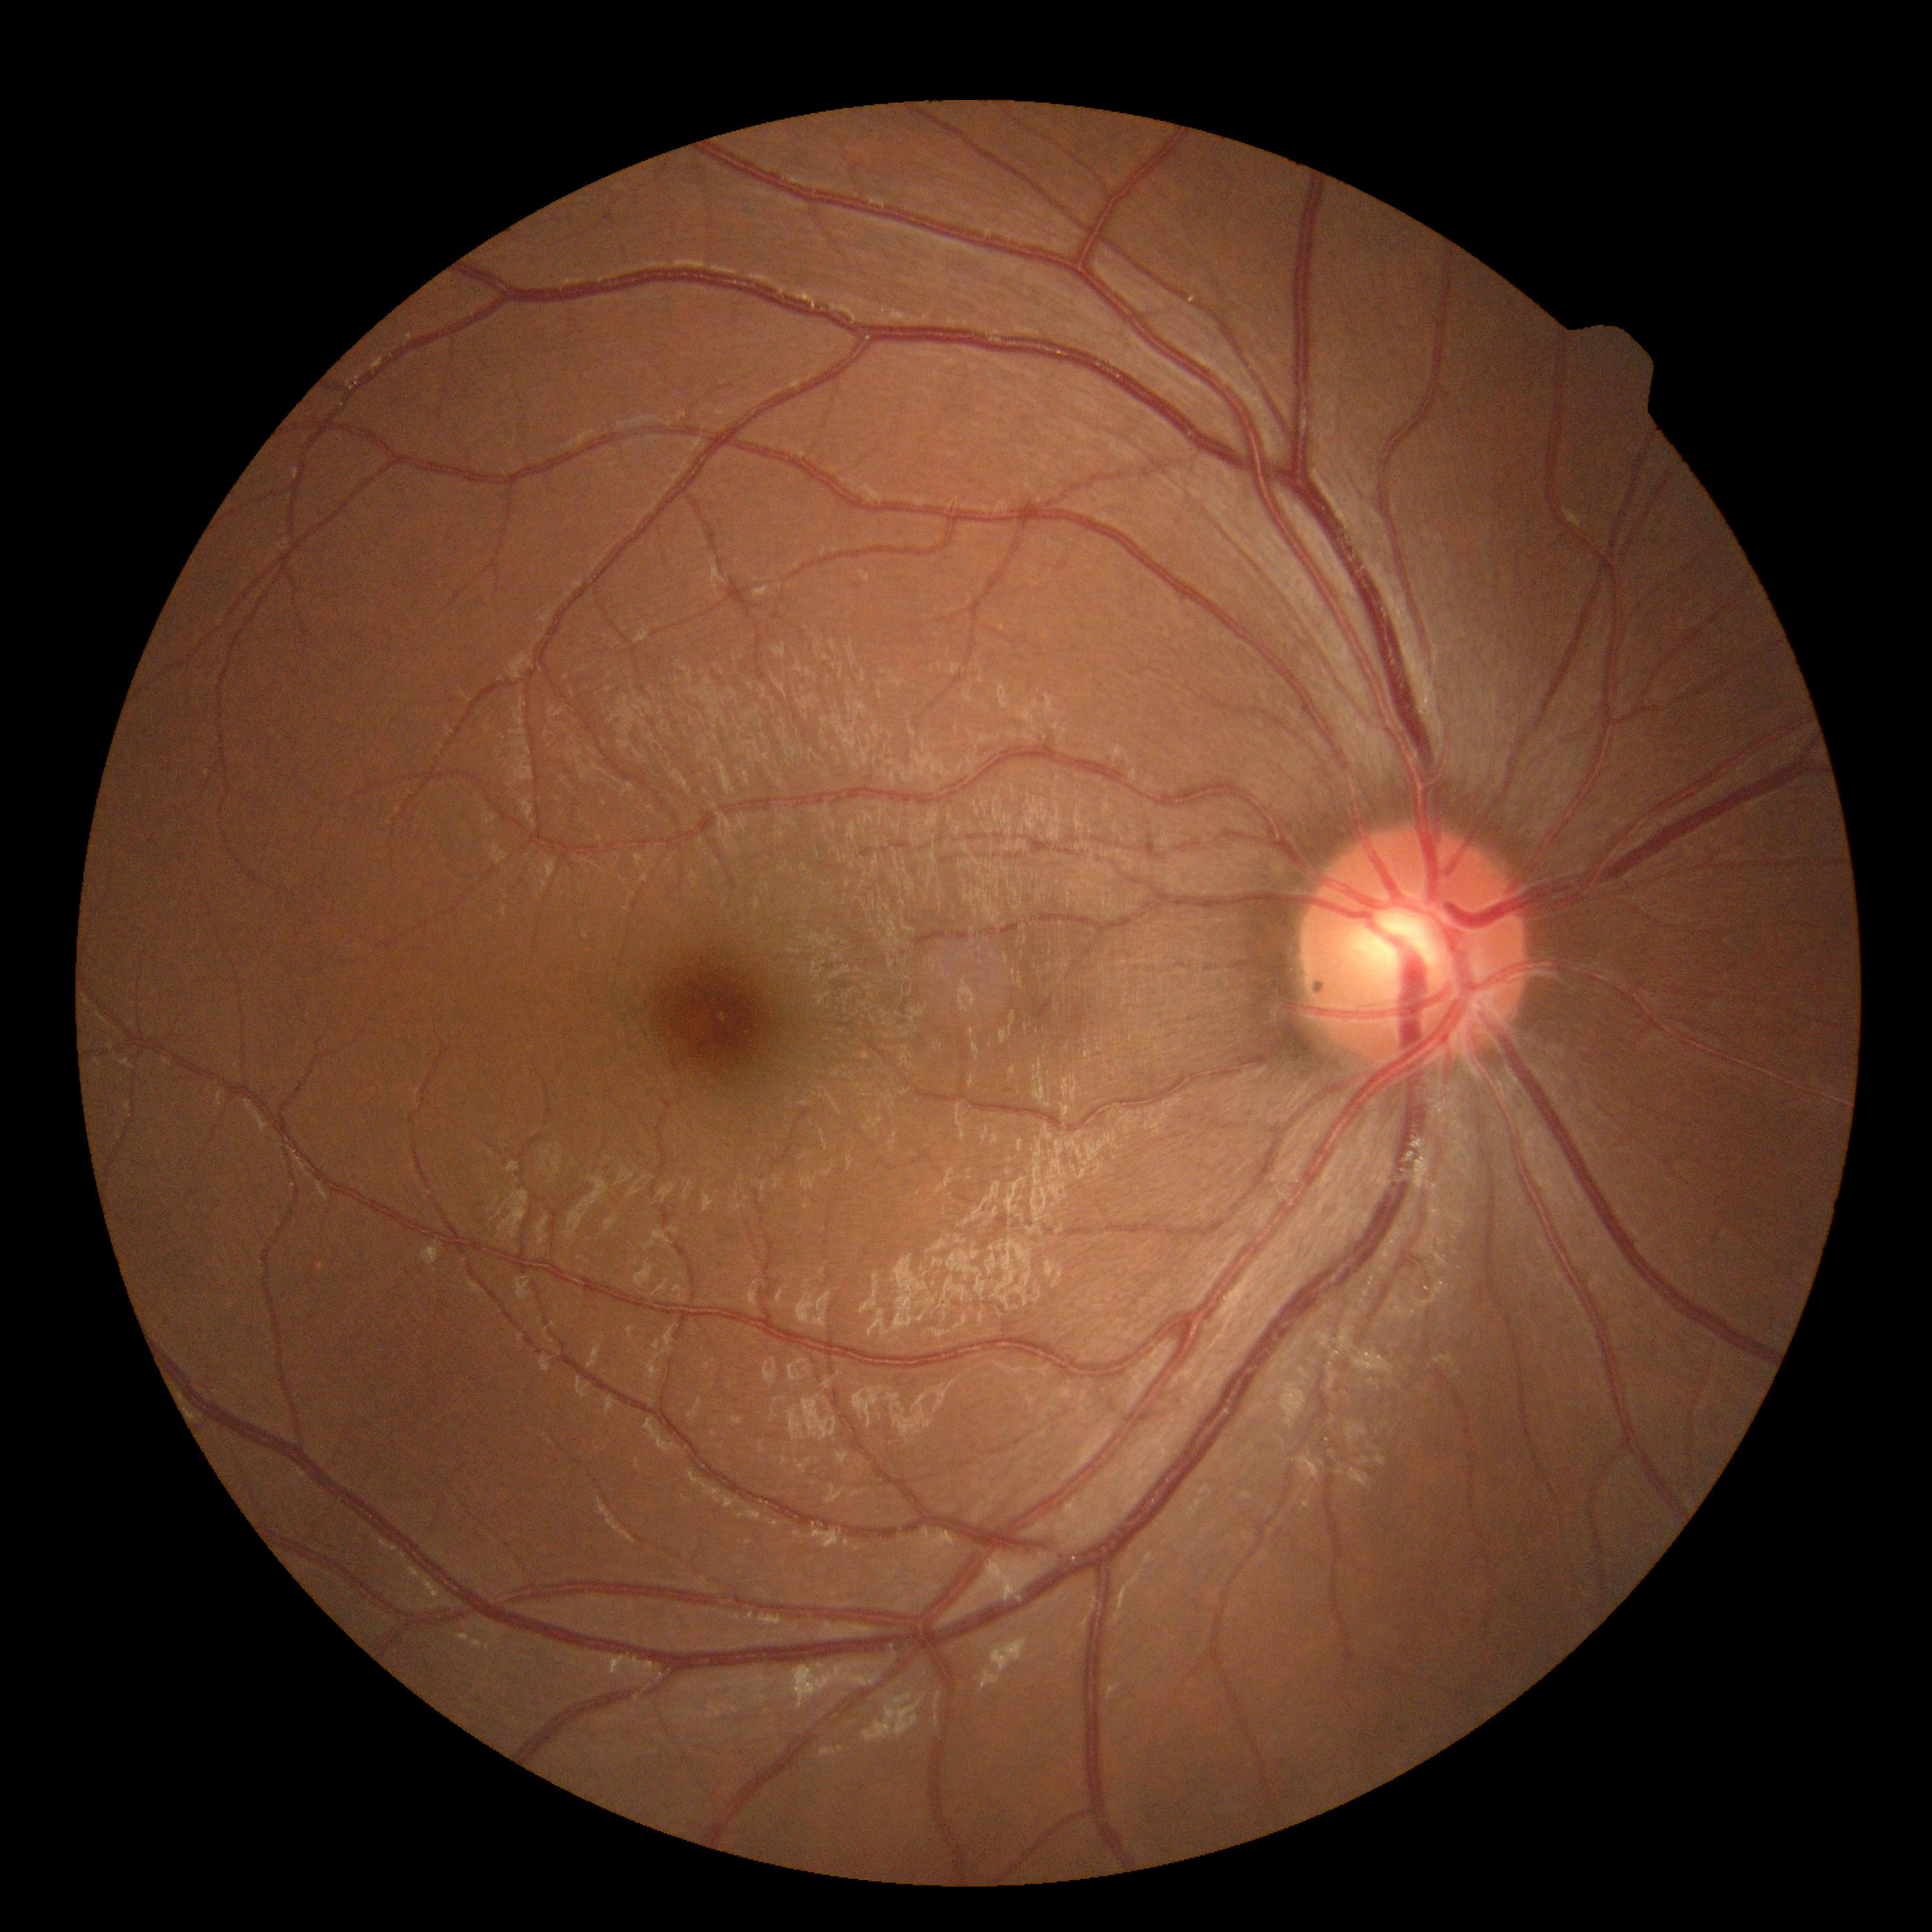 DR: 0/4.